Wide-field contact fundus photograph of an infant — 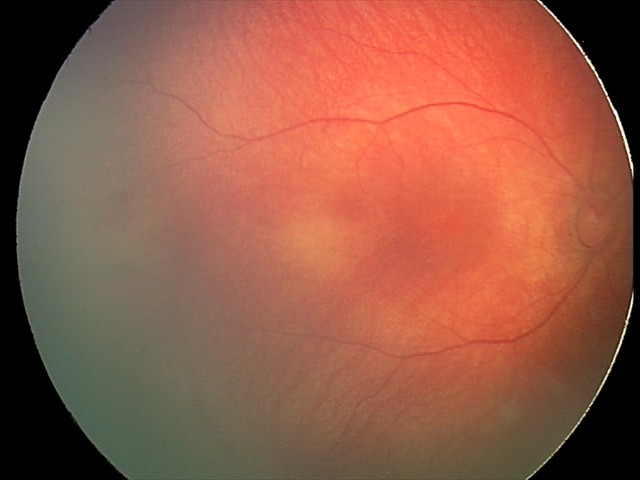

Series diagnosed as retinal hemorrhages.